Diabetic retinopathy graded by the modified Davis classification; 45-degree field of view:
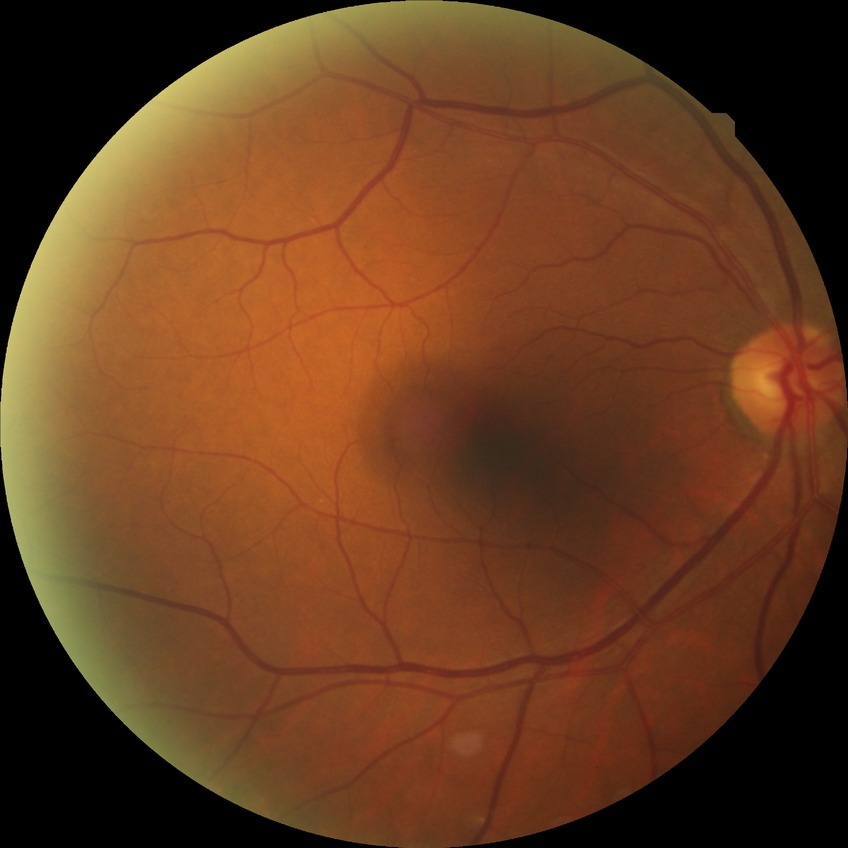
diabetic retinopathy (DR): NDR (no diabetic retinopathy).